Color fundus image:
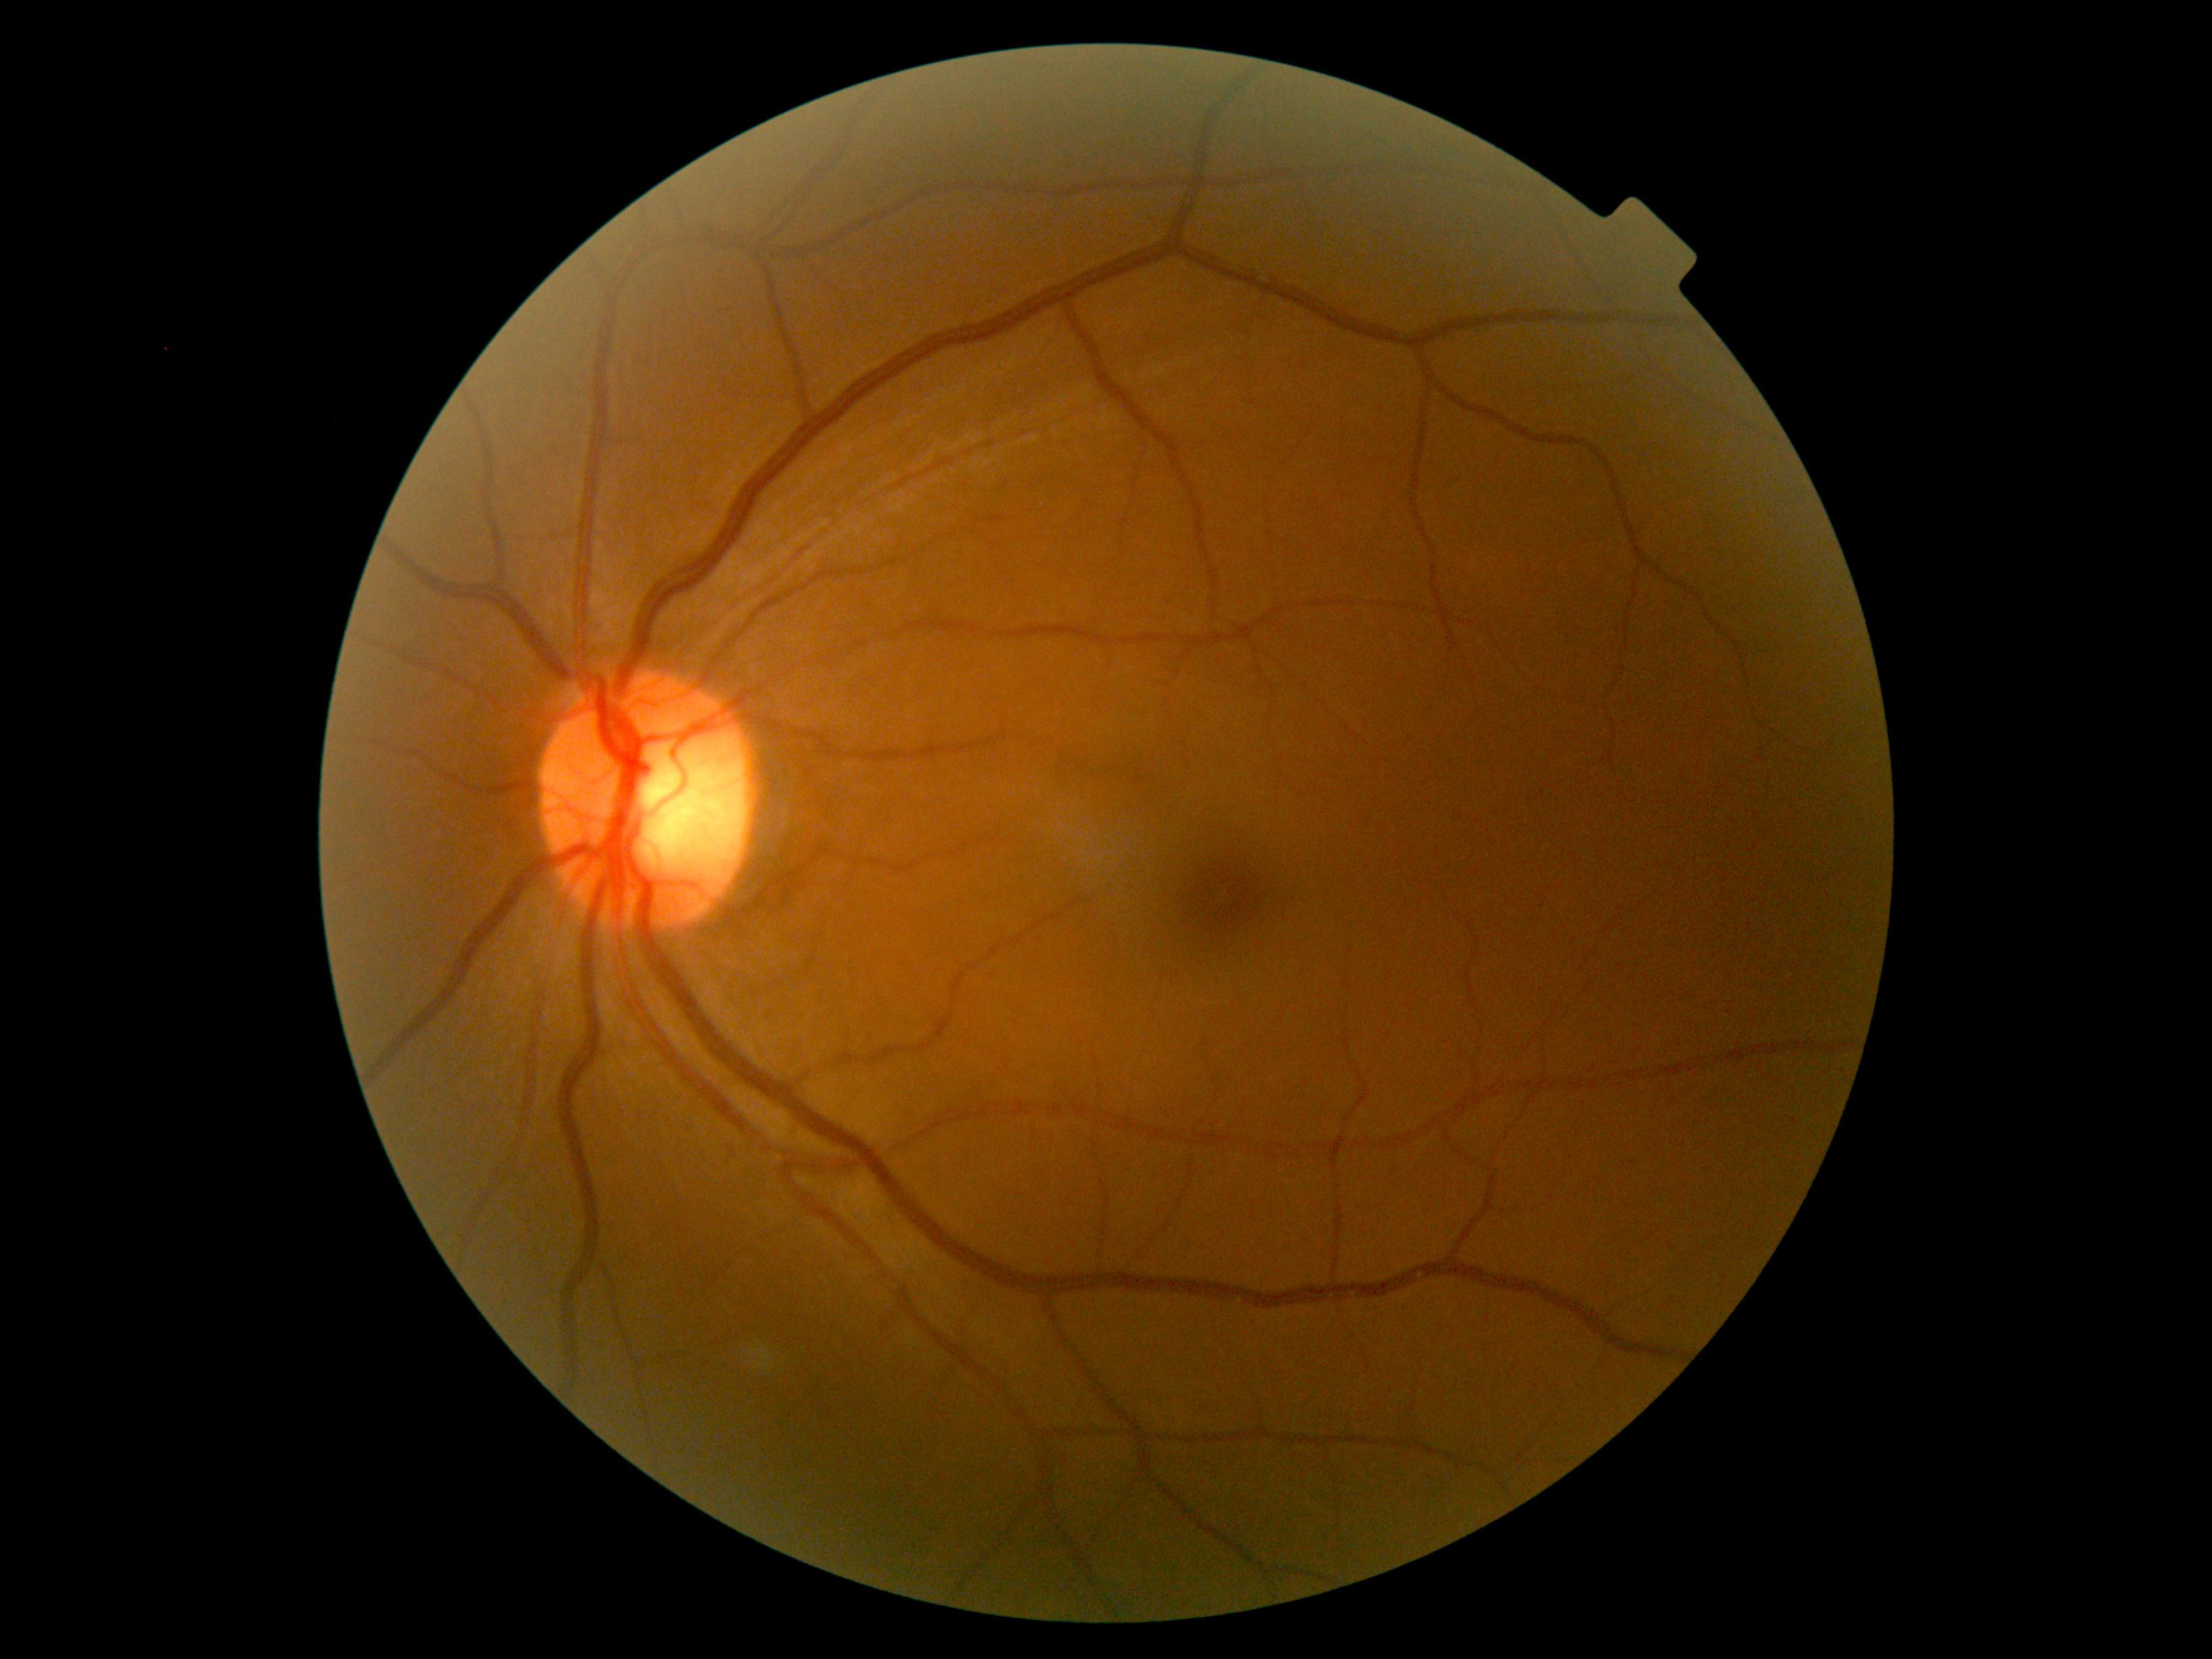 Findings:
• DR severity — no apparent retinopathy (grade 0)